2048 by 1536 pixels, fundus photo.
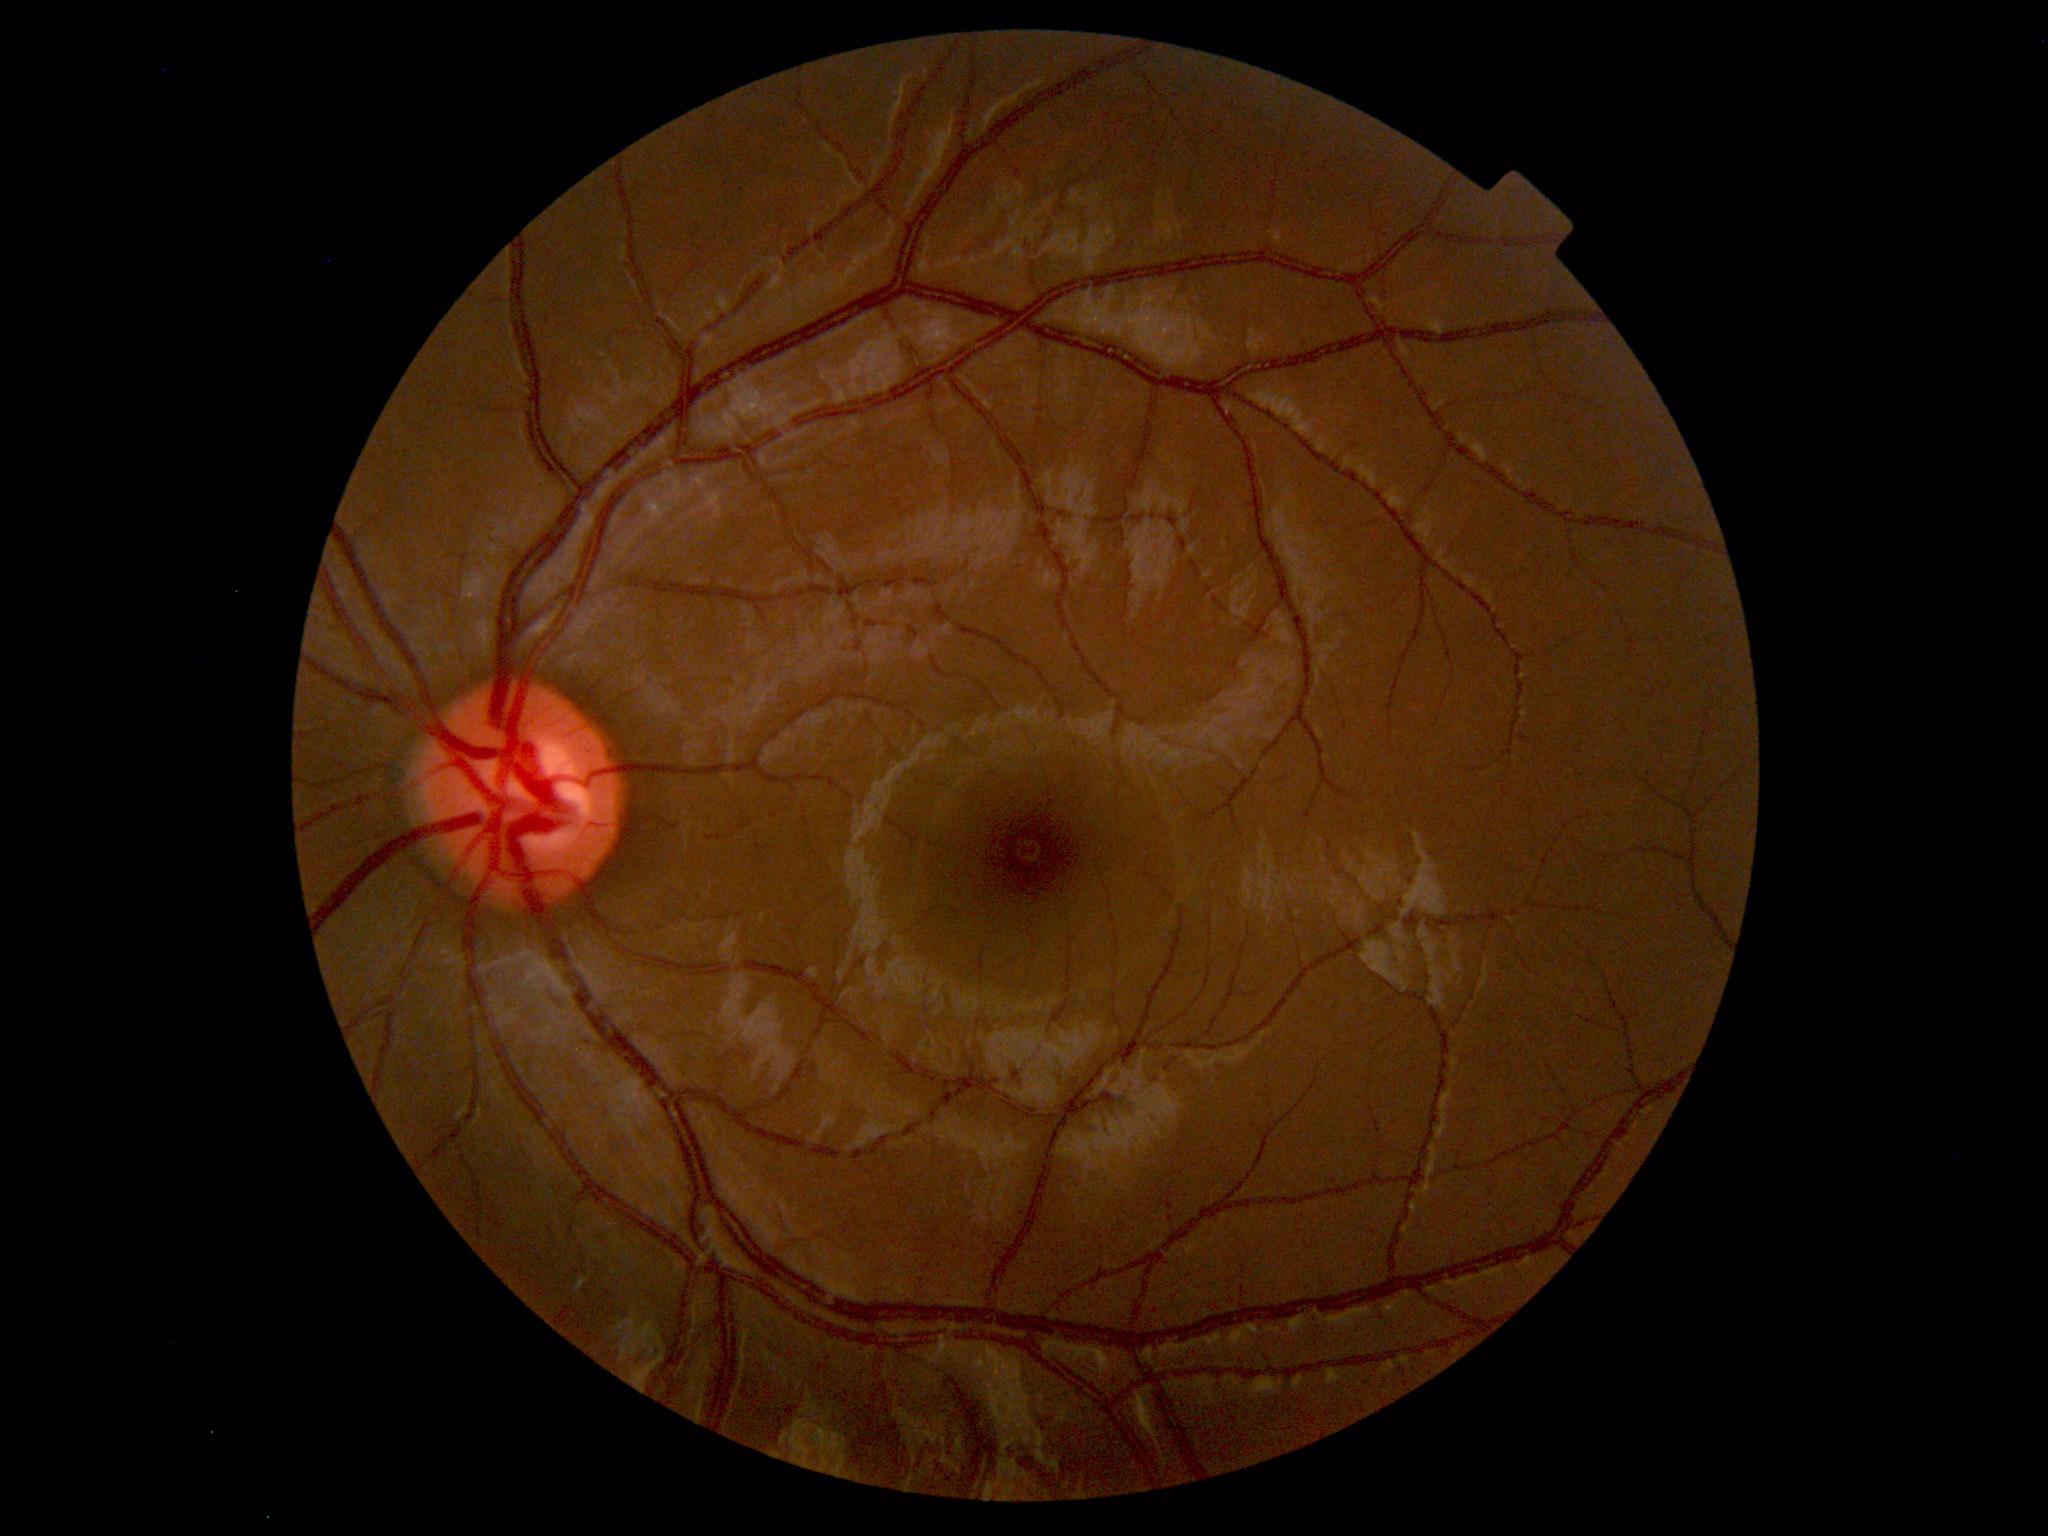 Findings: no abnormalities.